Diabetic retinopathy graded by the modified Davis classification, no pharmacologic dilation:
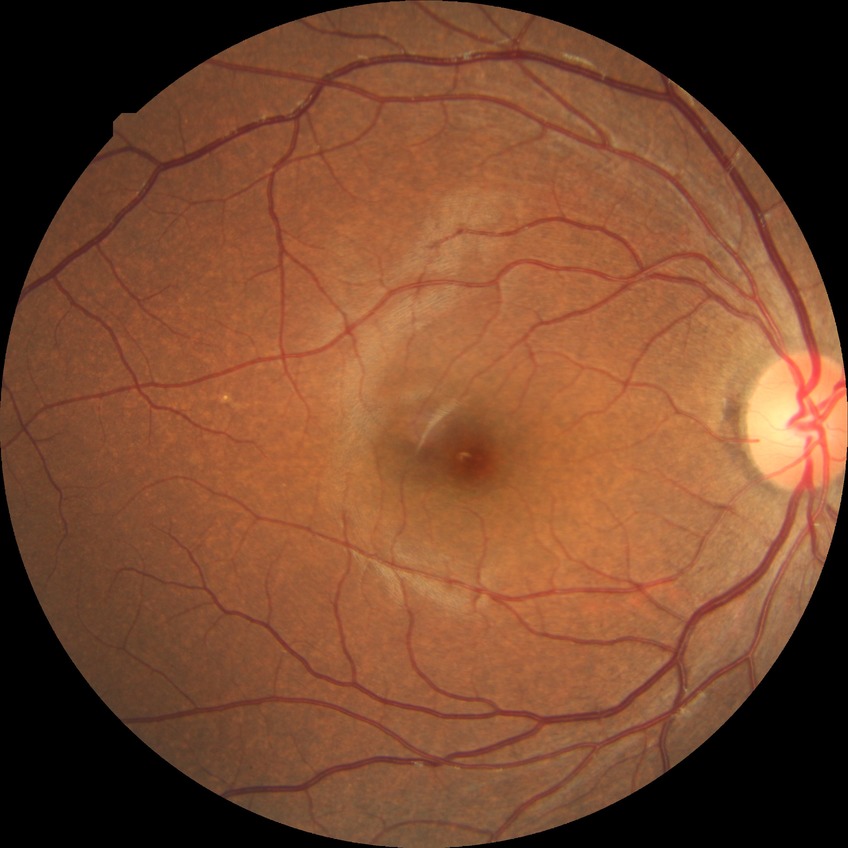
  davis_grade: NDR (no diabetic retinopathy)